Optic disc-centered crop from a color fundus photograph — 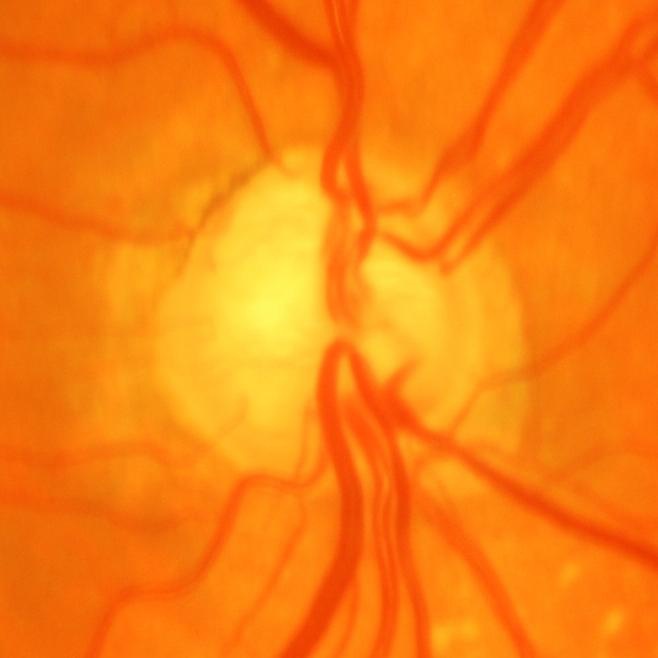 Consistent with glaucoma.